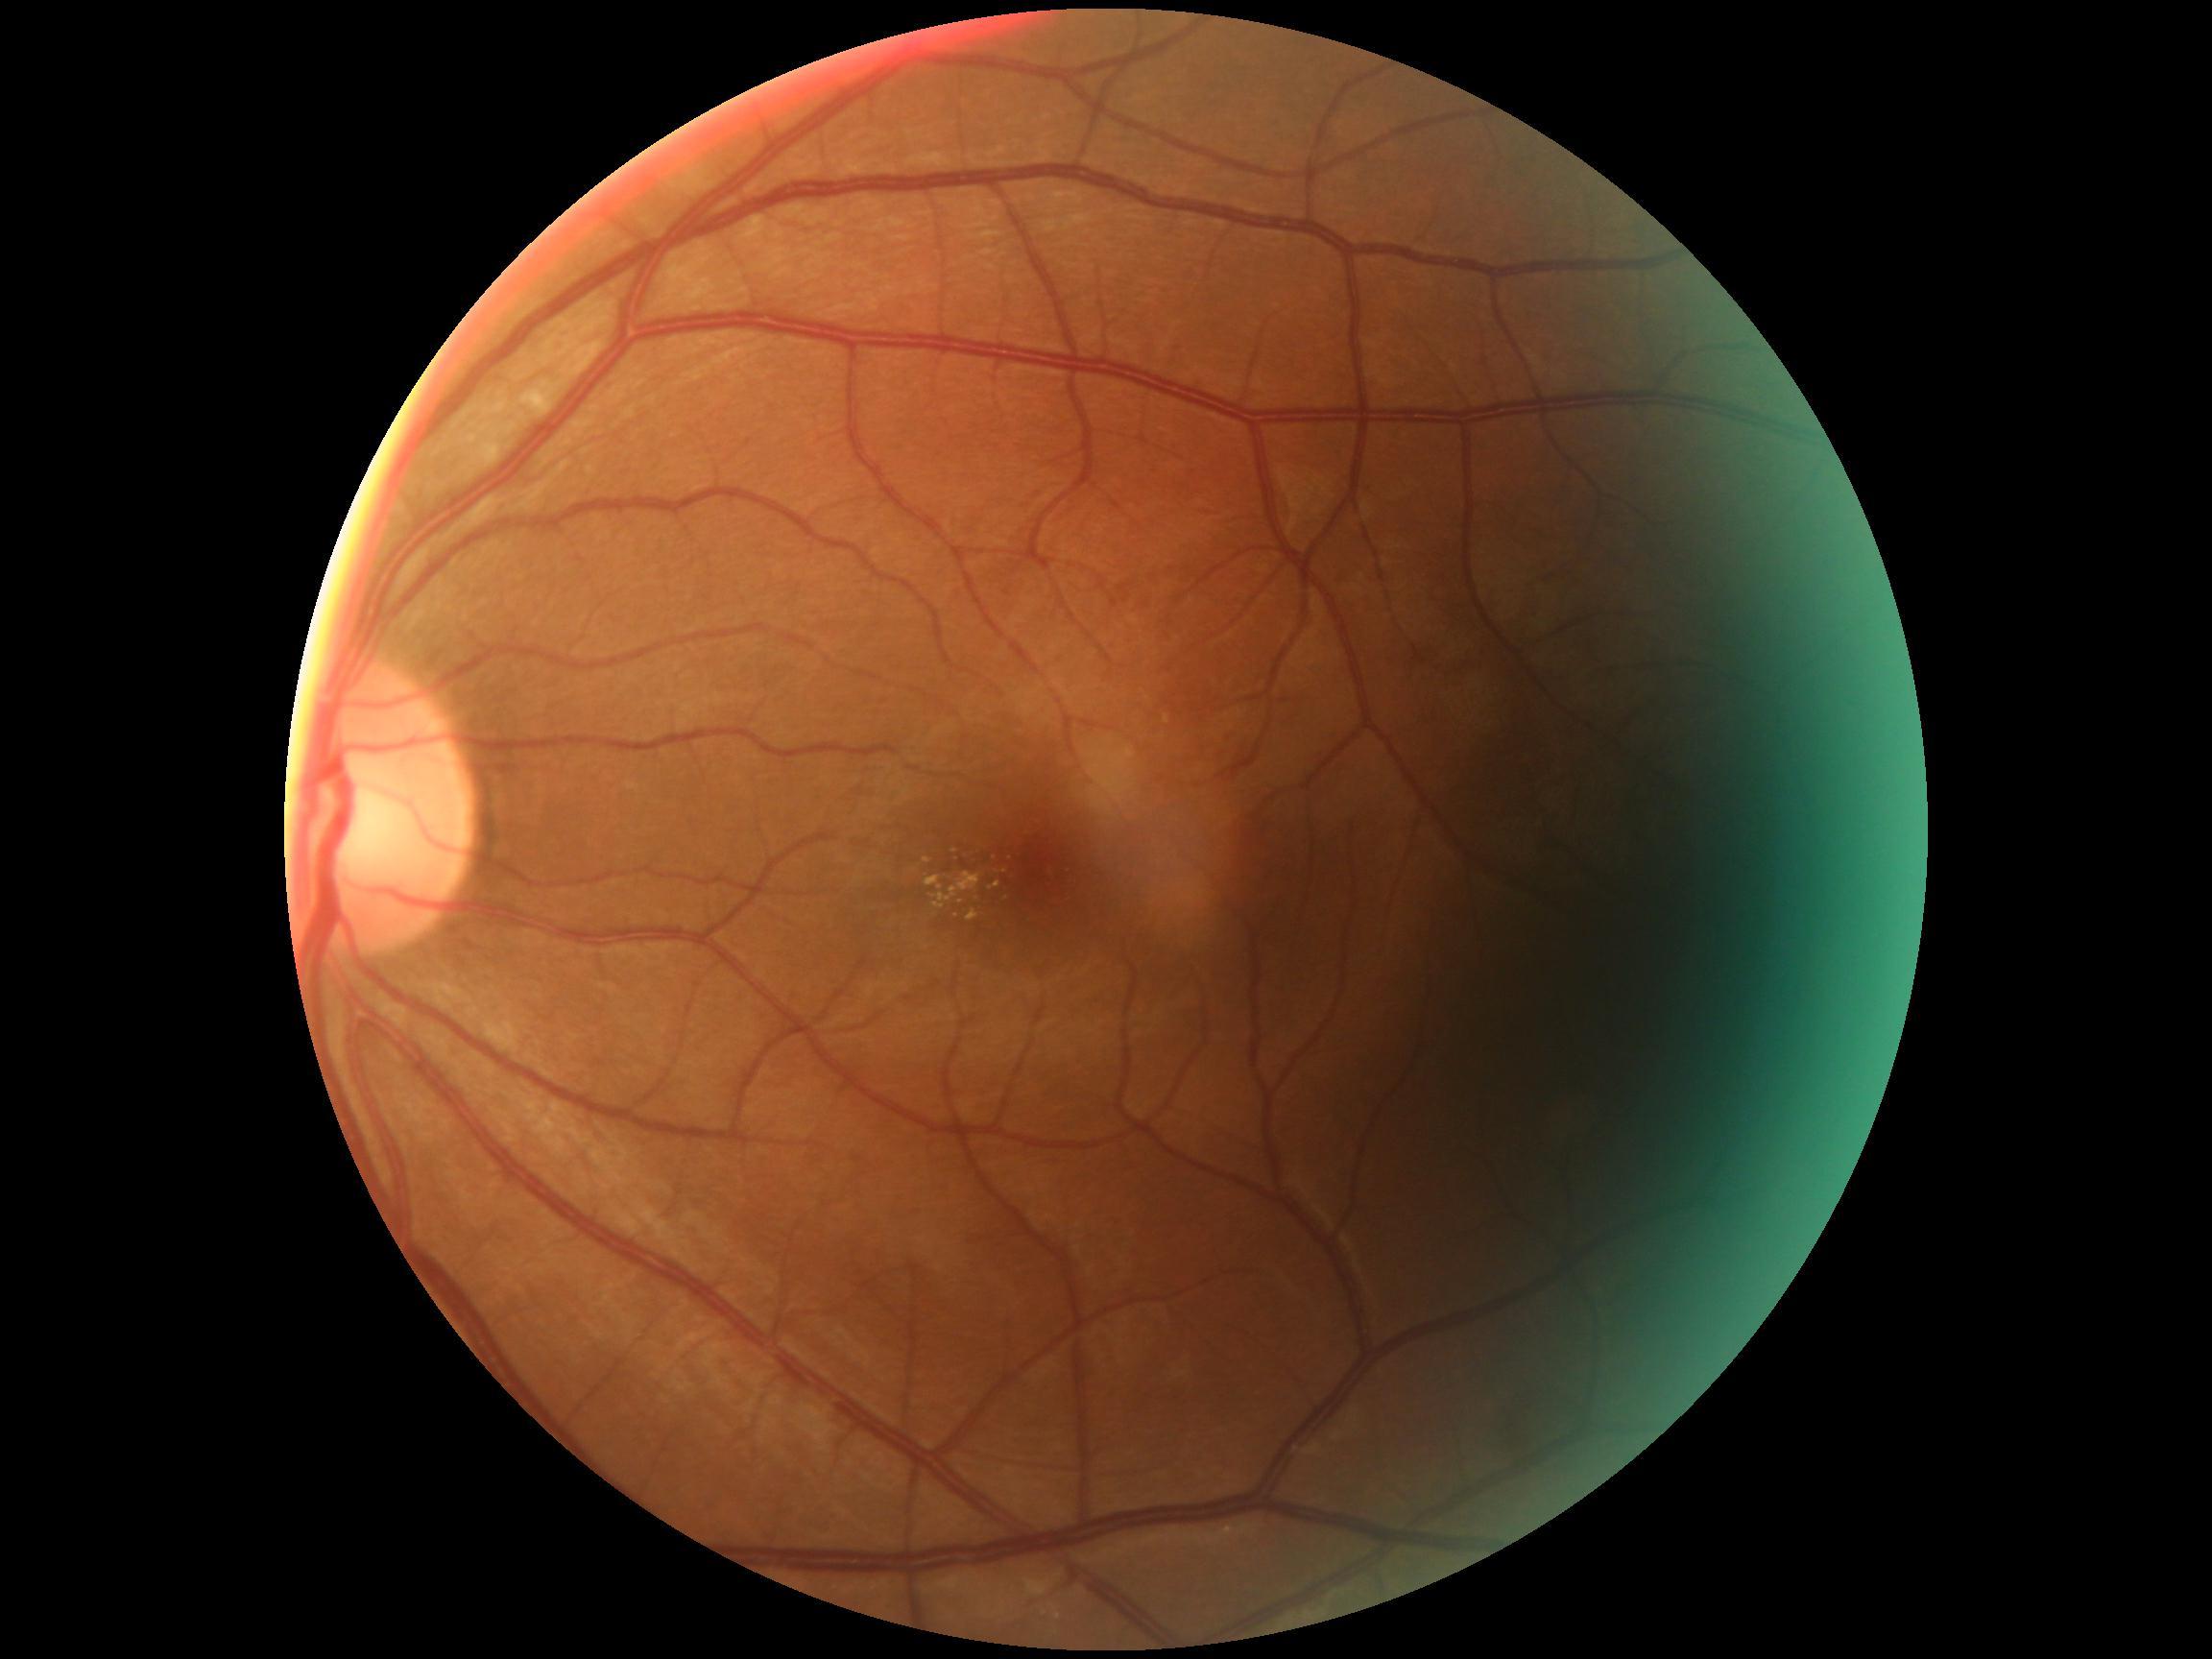 retinopathy = grade 2 (moderate NPDR).